2048x1536px; CFP; 45° FOV.
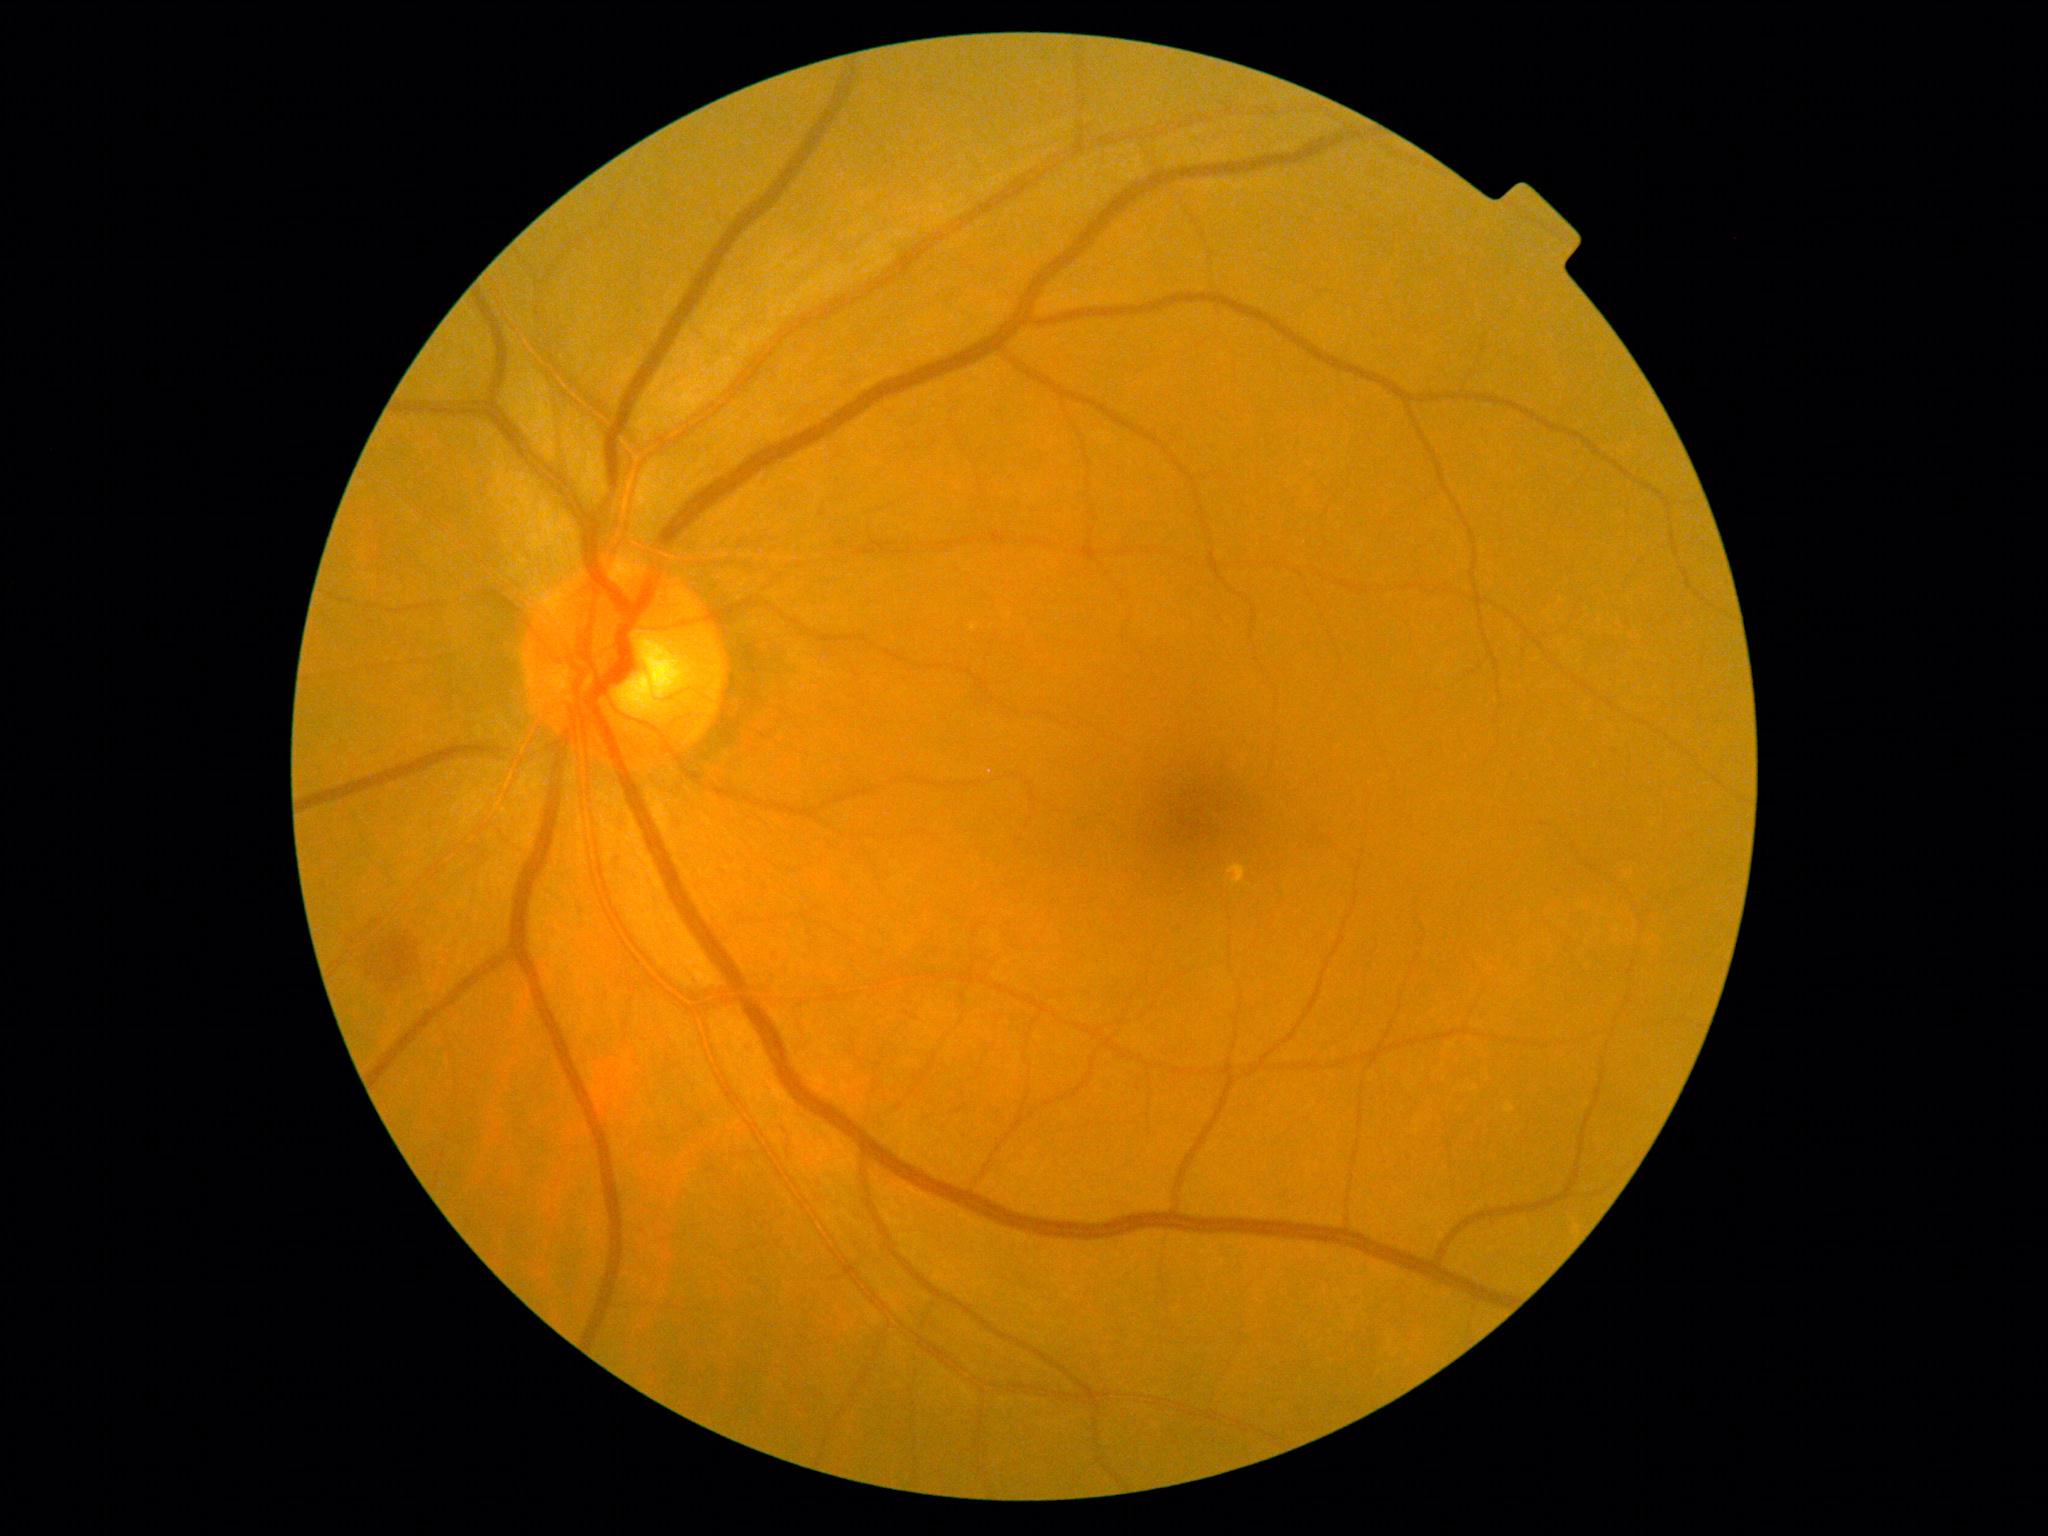 {"dr_grade": "moderate non-proliferative diabetic retinopathy (2) — more than just microaneurysms but less than severe NPDR"}